Graded on the modified Davis scale. No pharmacologic dilation. 45° field of view.
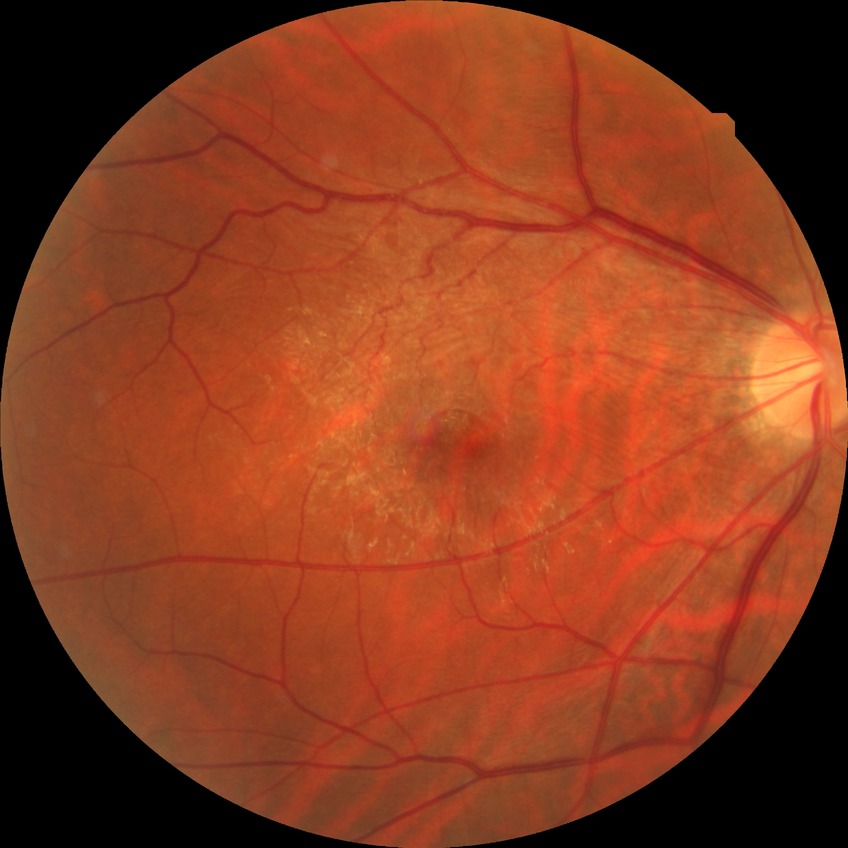
Retinopathy stage is no diabetic retinopathy.